Acquired with a NIDEK AFC-230 · 45 degree fundus photograph — 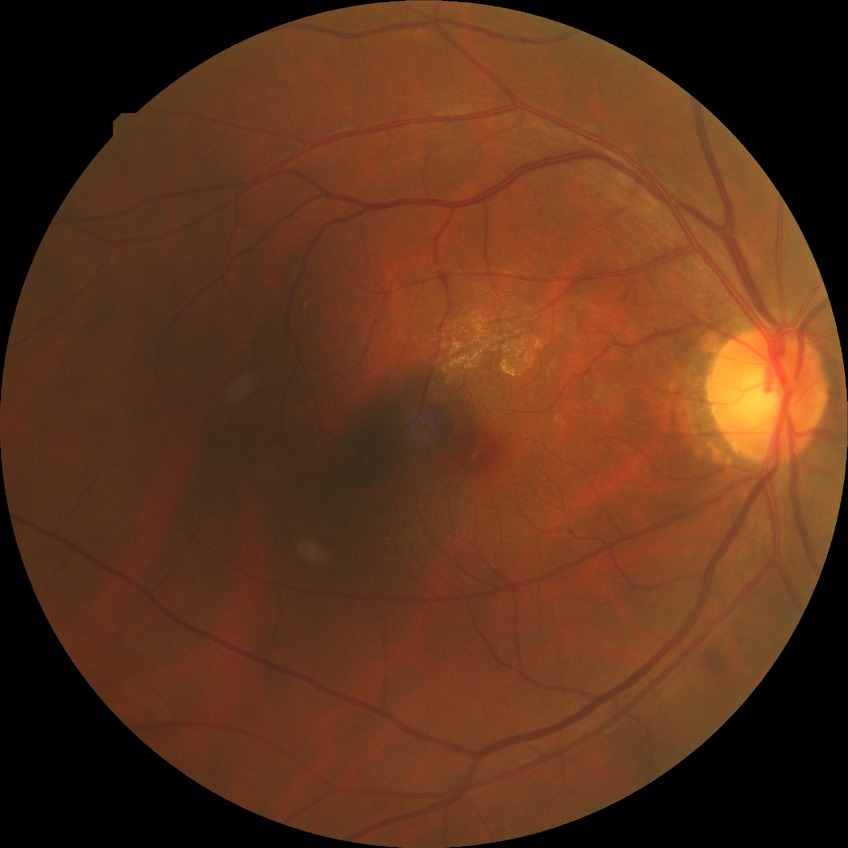
Diabetic retinopathy (DR) is no diabetic retinopathy (NDR).